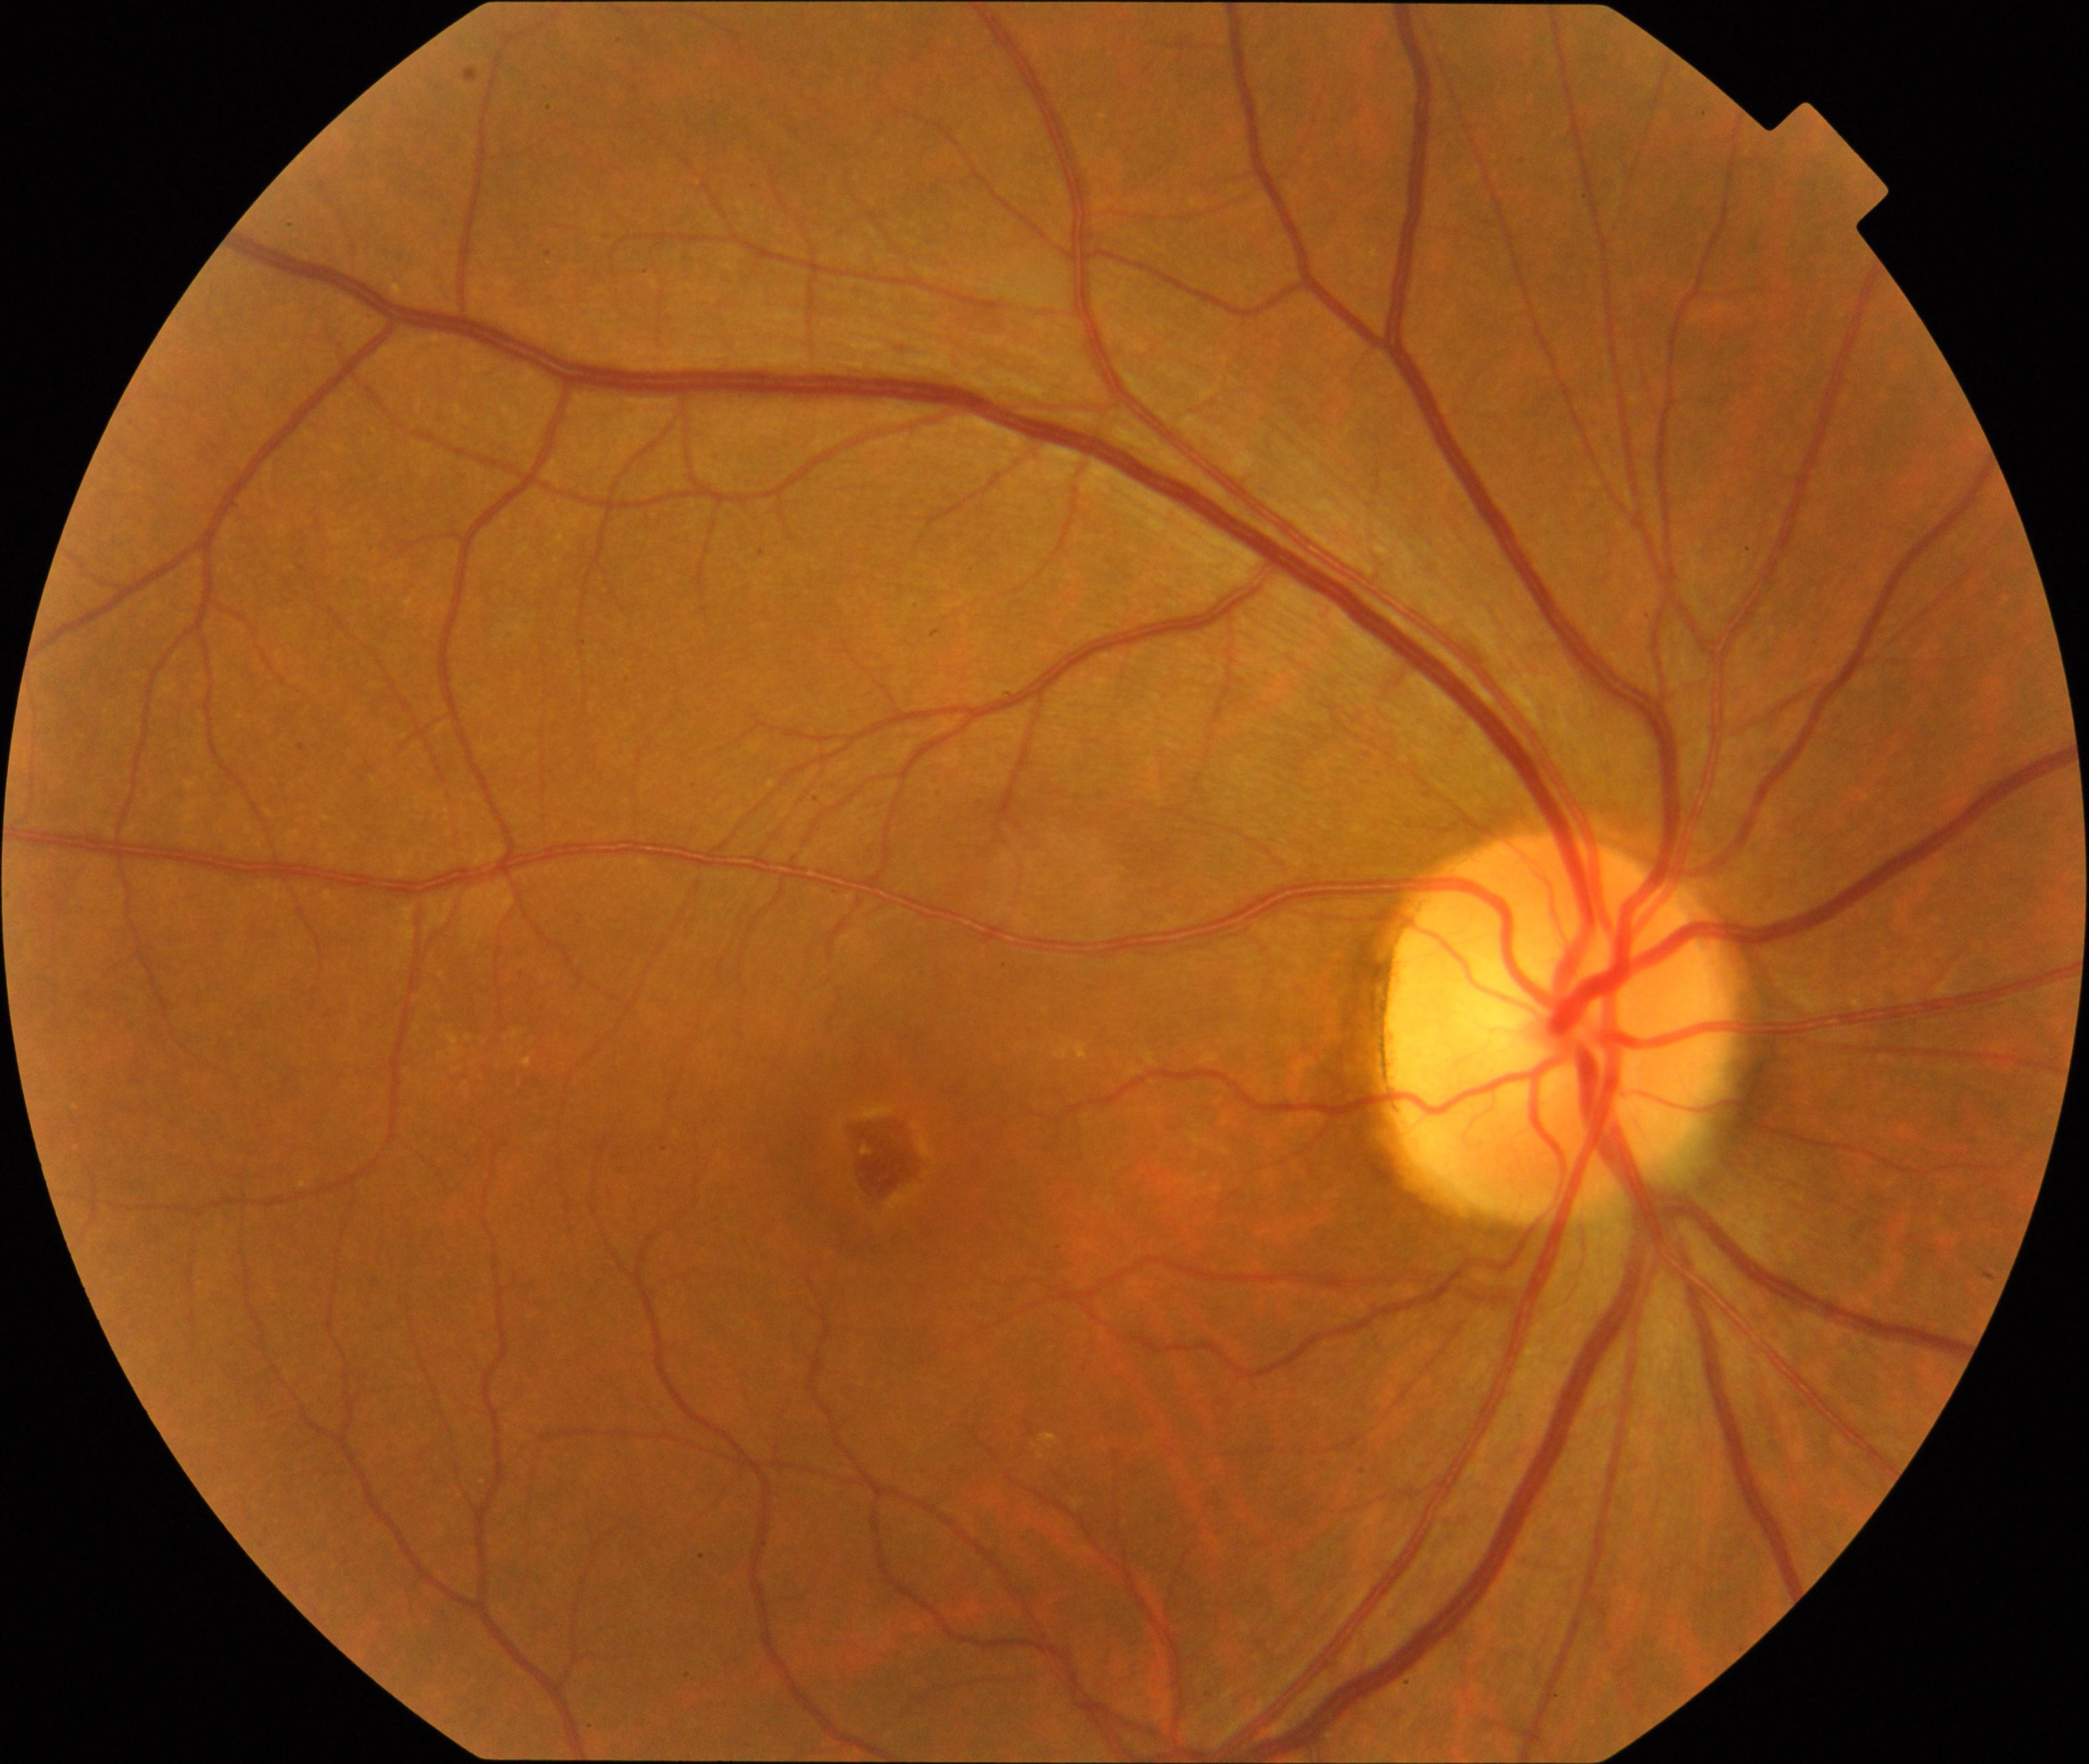
Findings: MH (macular hole).